45° field of view. 412 by 310 pixels.
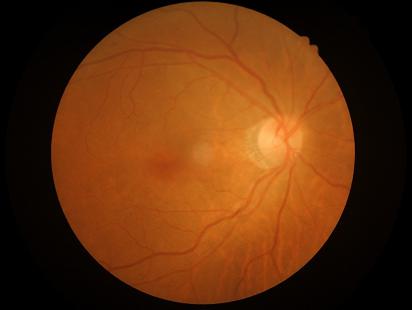 Overall image quality: adequate for clinical interpretation
Contrast: wide intensity range, structures distinguishable